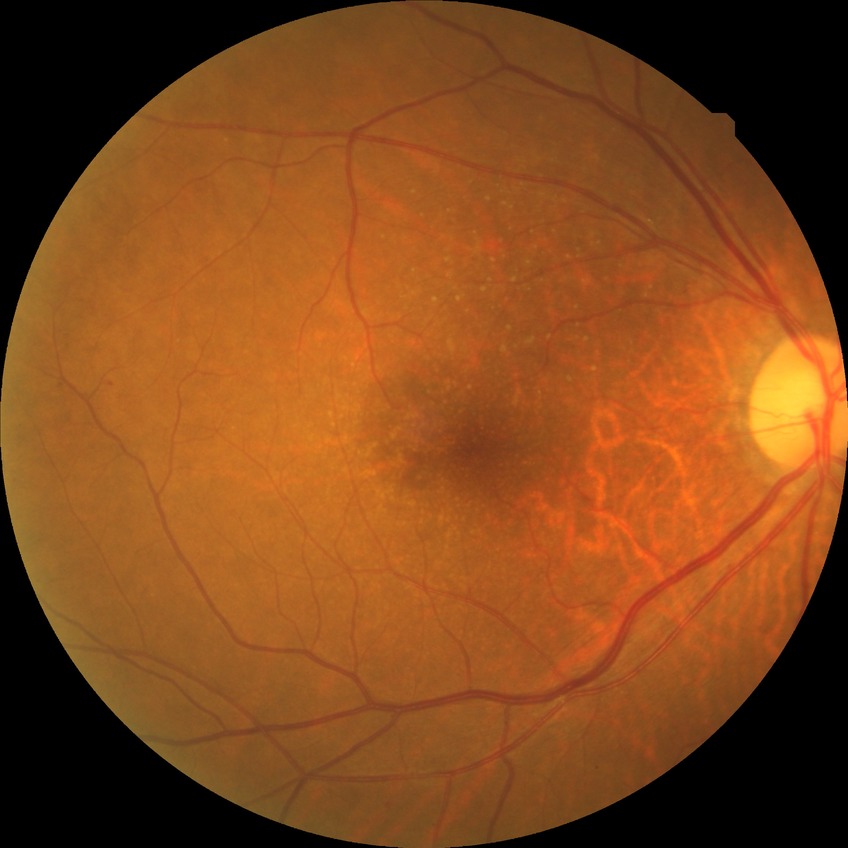

Annotations:
• diabetic retinopathy (DR): no diabetic retinopathy (NDR)